2228 by 1652 pixels, 50-degree field of view, posterior pole field covering the optic disc and macula, color fundus image, dilated-pupil acquisition: 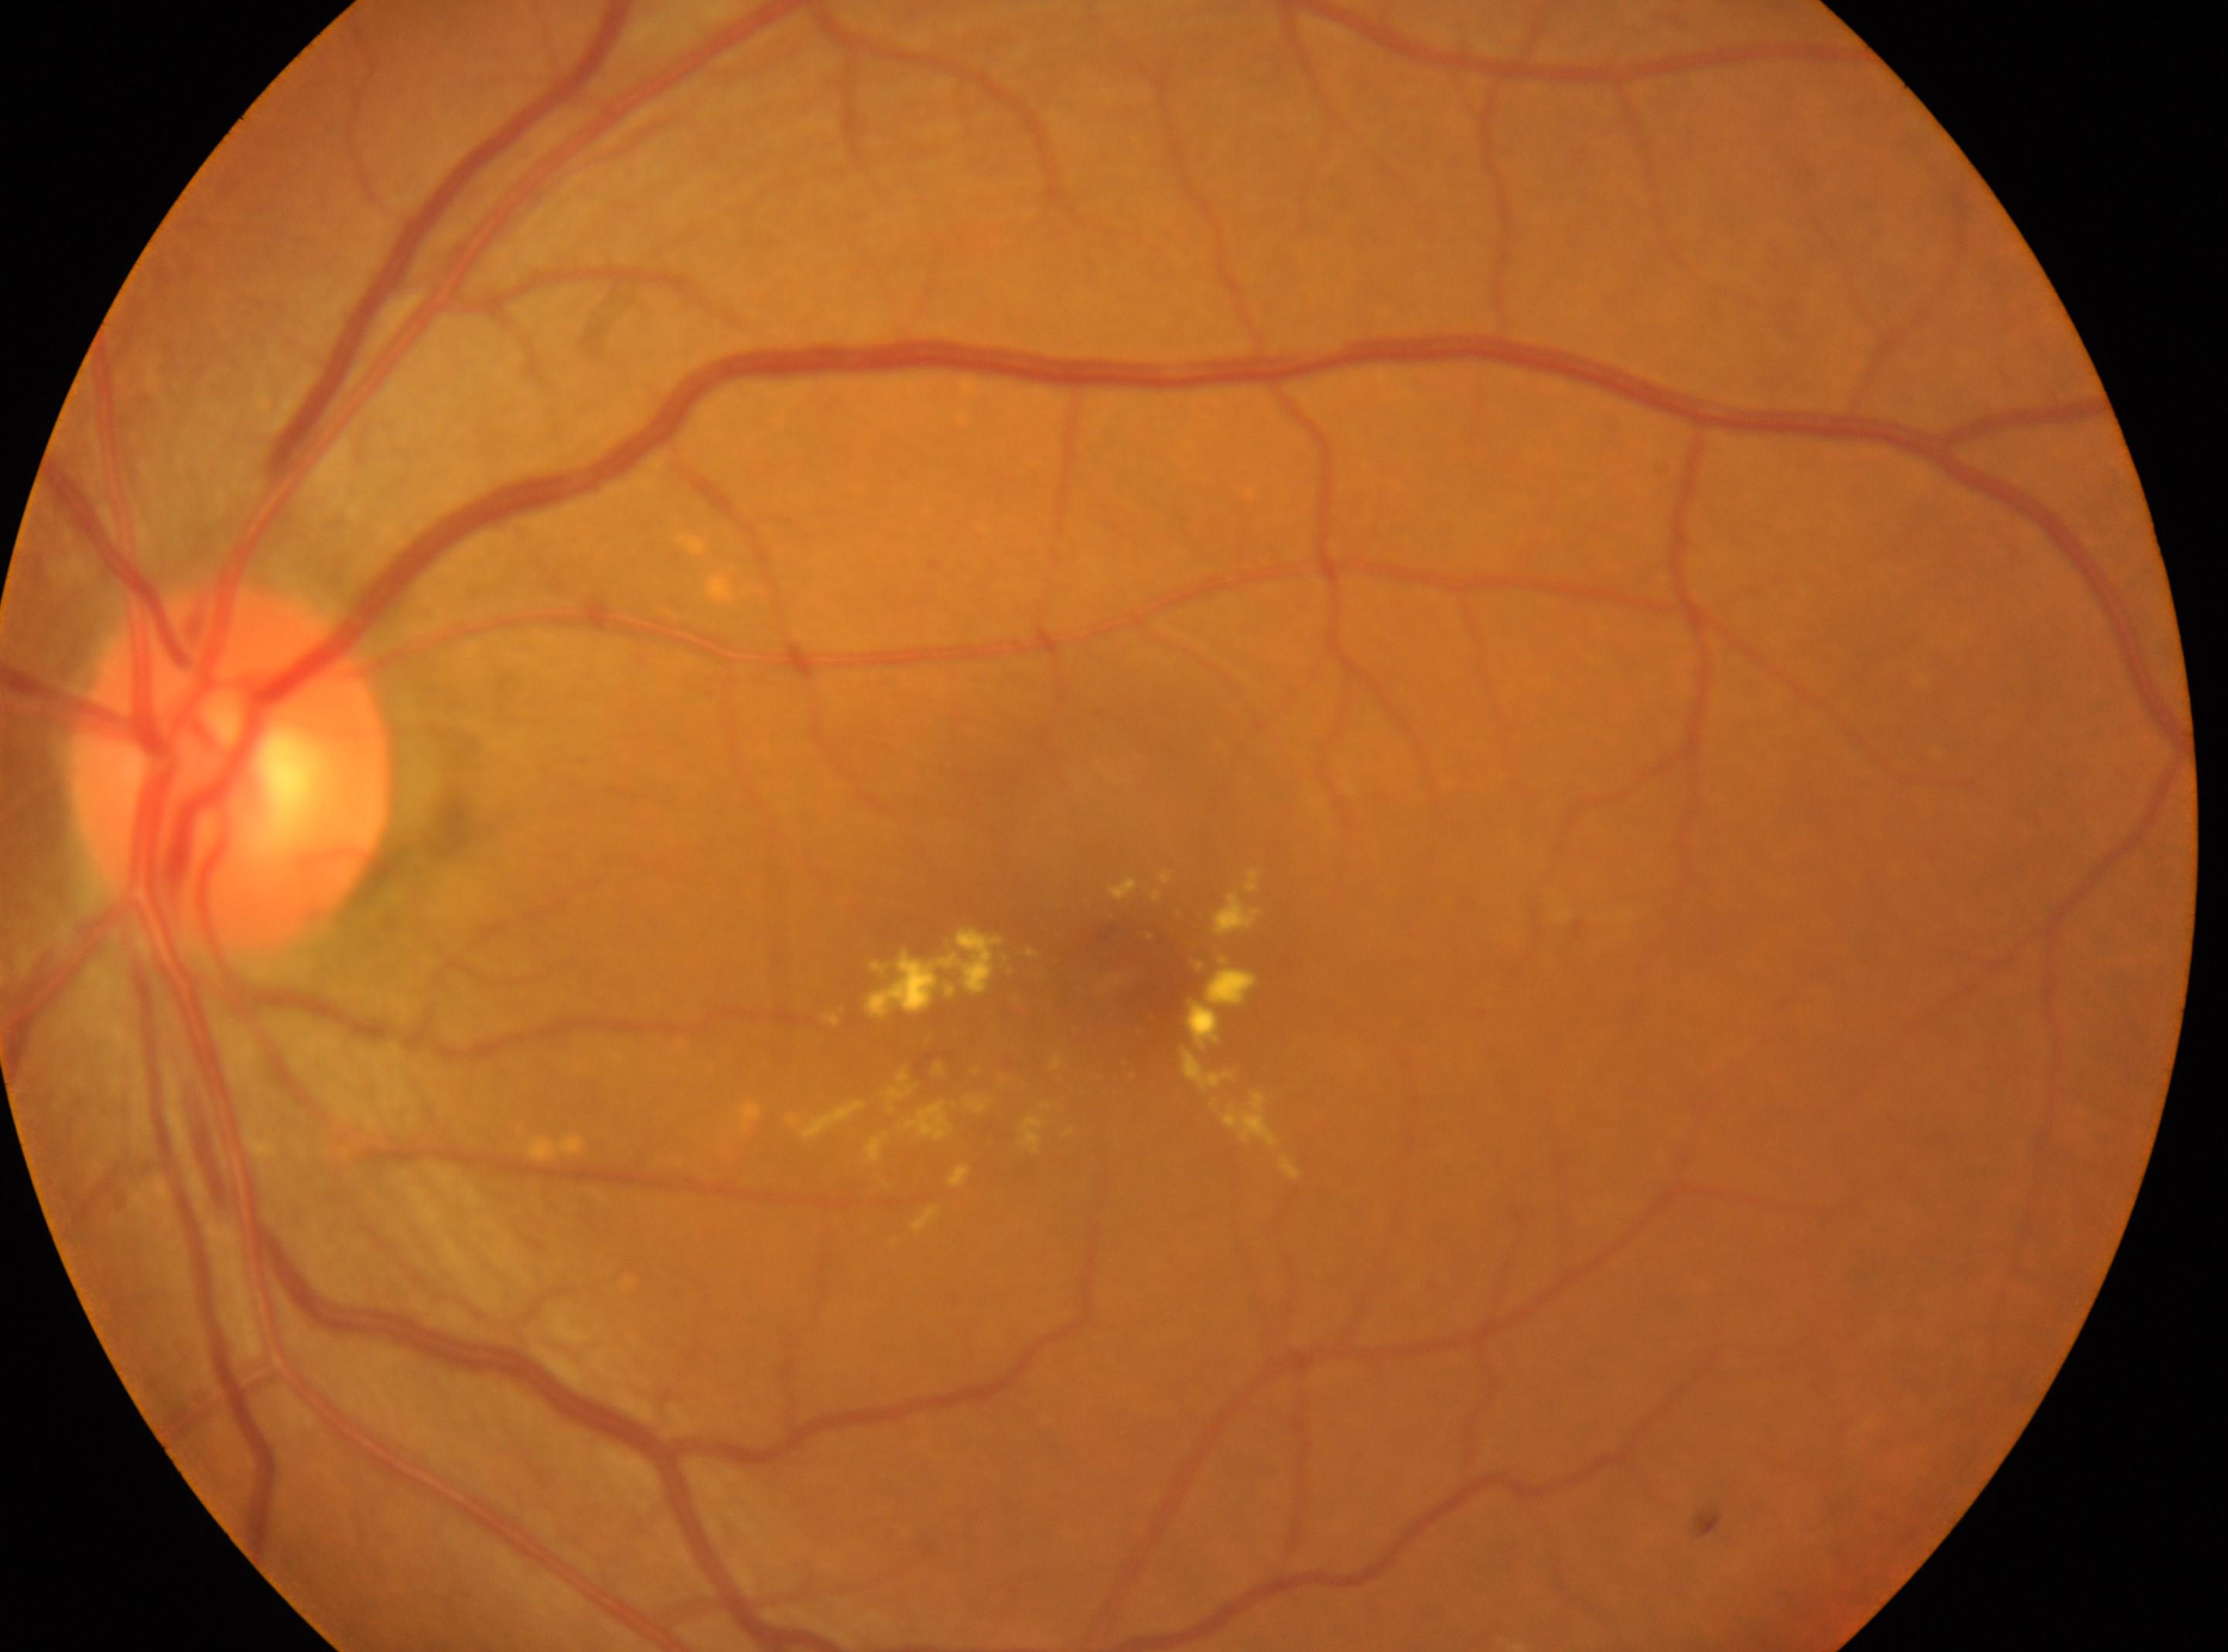
| key | value |
|---|---|
| laterality | left eye |
| macular center | (1116,978) |
| the optic disc | (234,767) |
| DR grade | 2/4 — more than just microaneurysms but less than severe NPDR |